45° FOV.
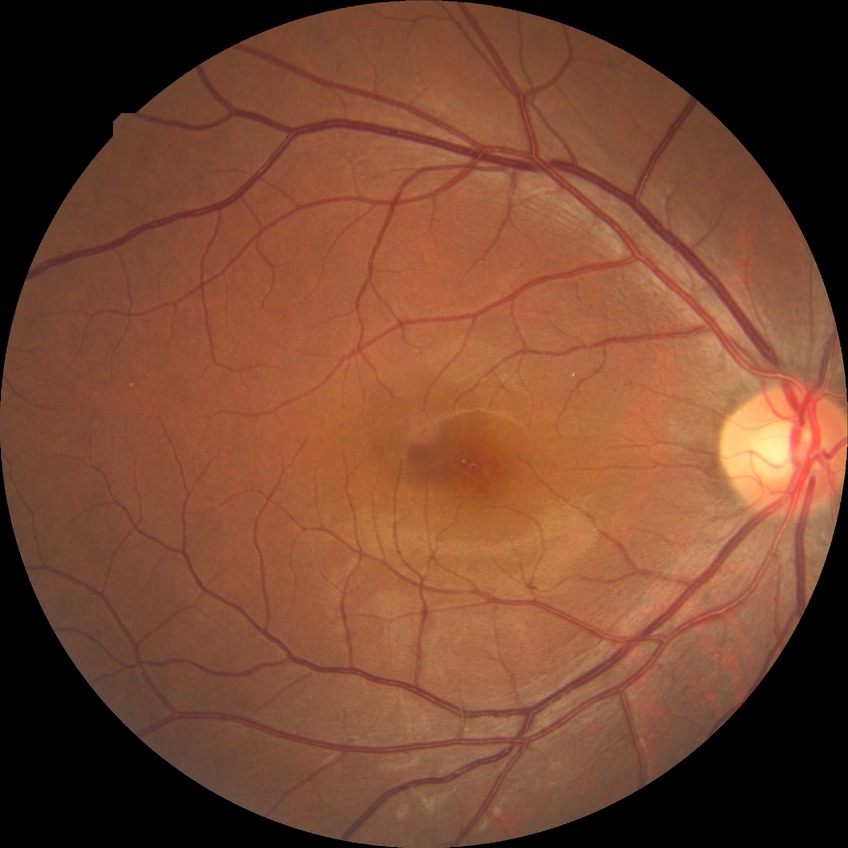 Diabetic retinopathy stage: no diabetic retinopathy.